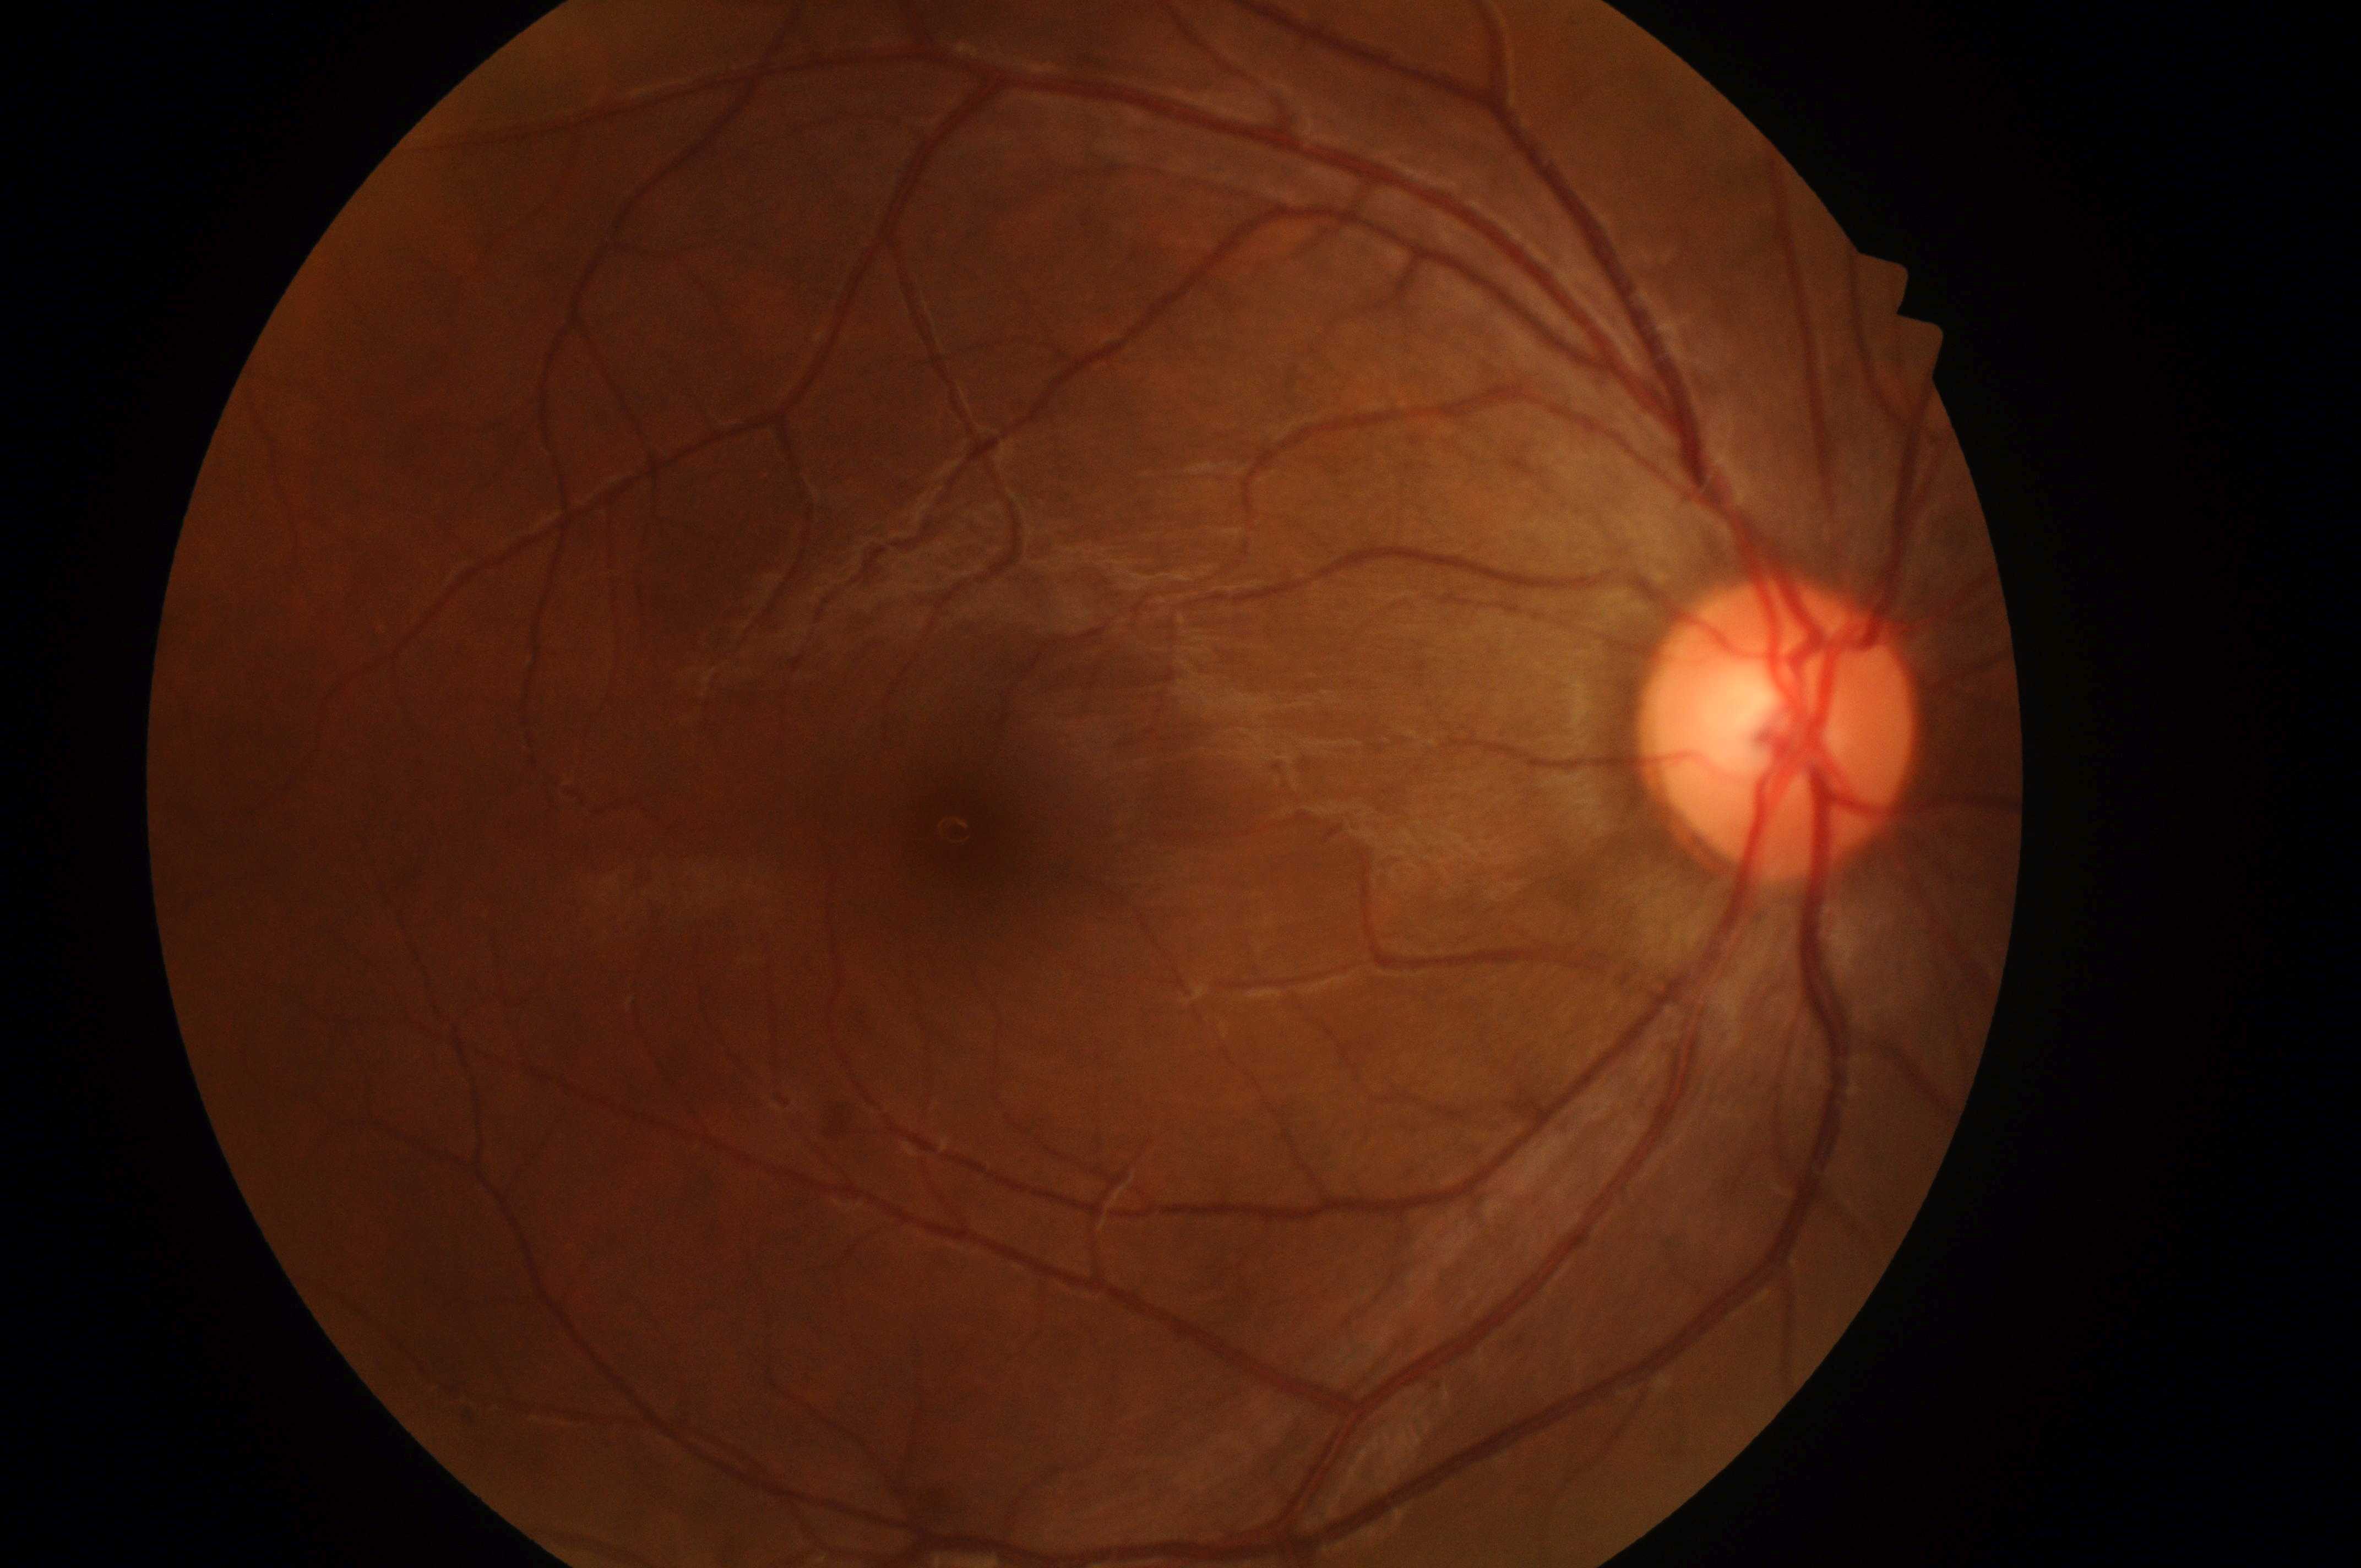
Q: Where is the optic disc?
A: (x: 1786, y: 738)
Q: DME grade?
A: grade 0 (no risk)
Q: Any diabetic retinopathy?
A: No DR or DME findings
Q: Where is the fovea?
A: (x: 976, y: 845)
Q: What is the DR grade?
A: no apparent retinopathy (grade 0)
Q: What is the laterality?
A: the right eye